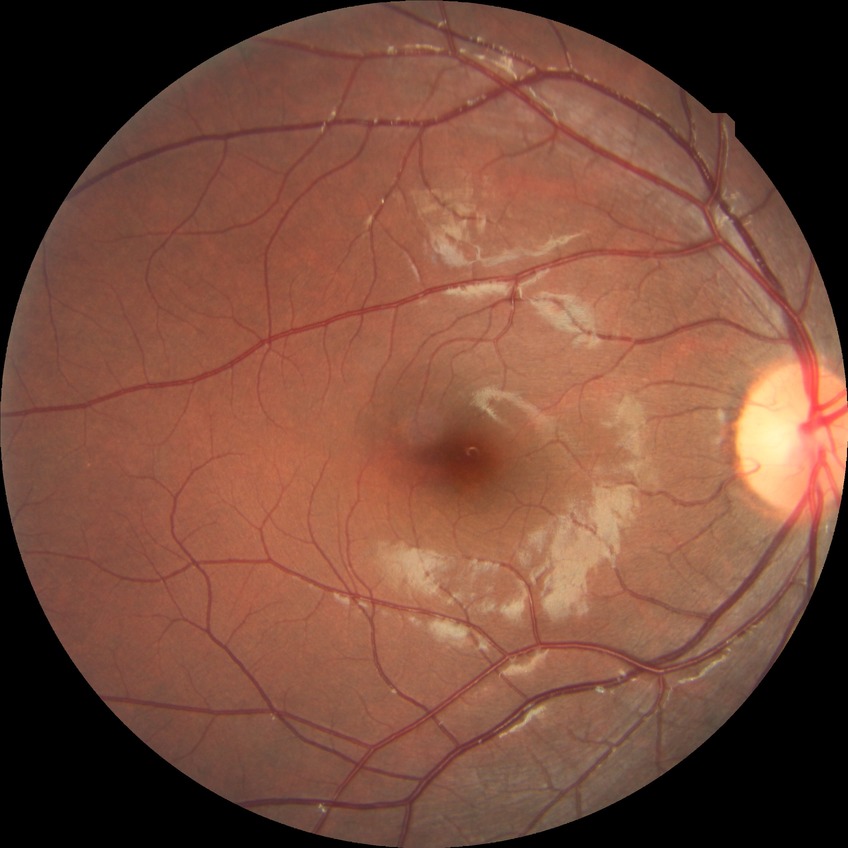
  davis_grade: no diabetic retinopathy